Image size 2352x1568: 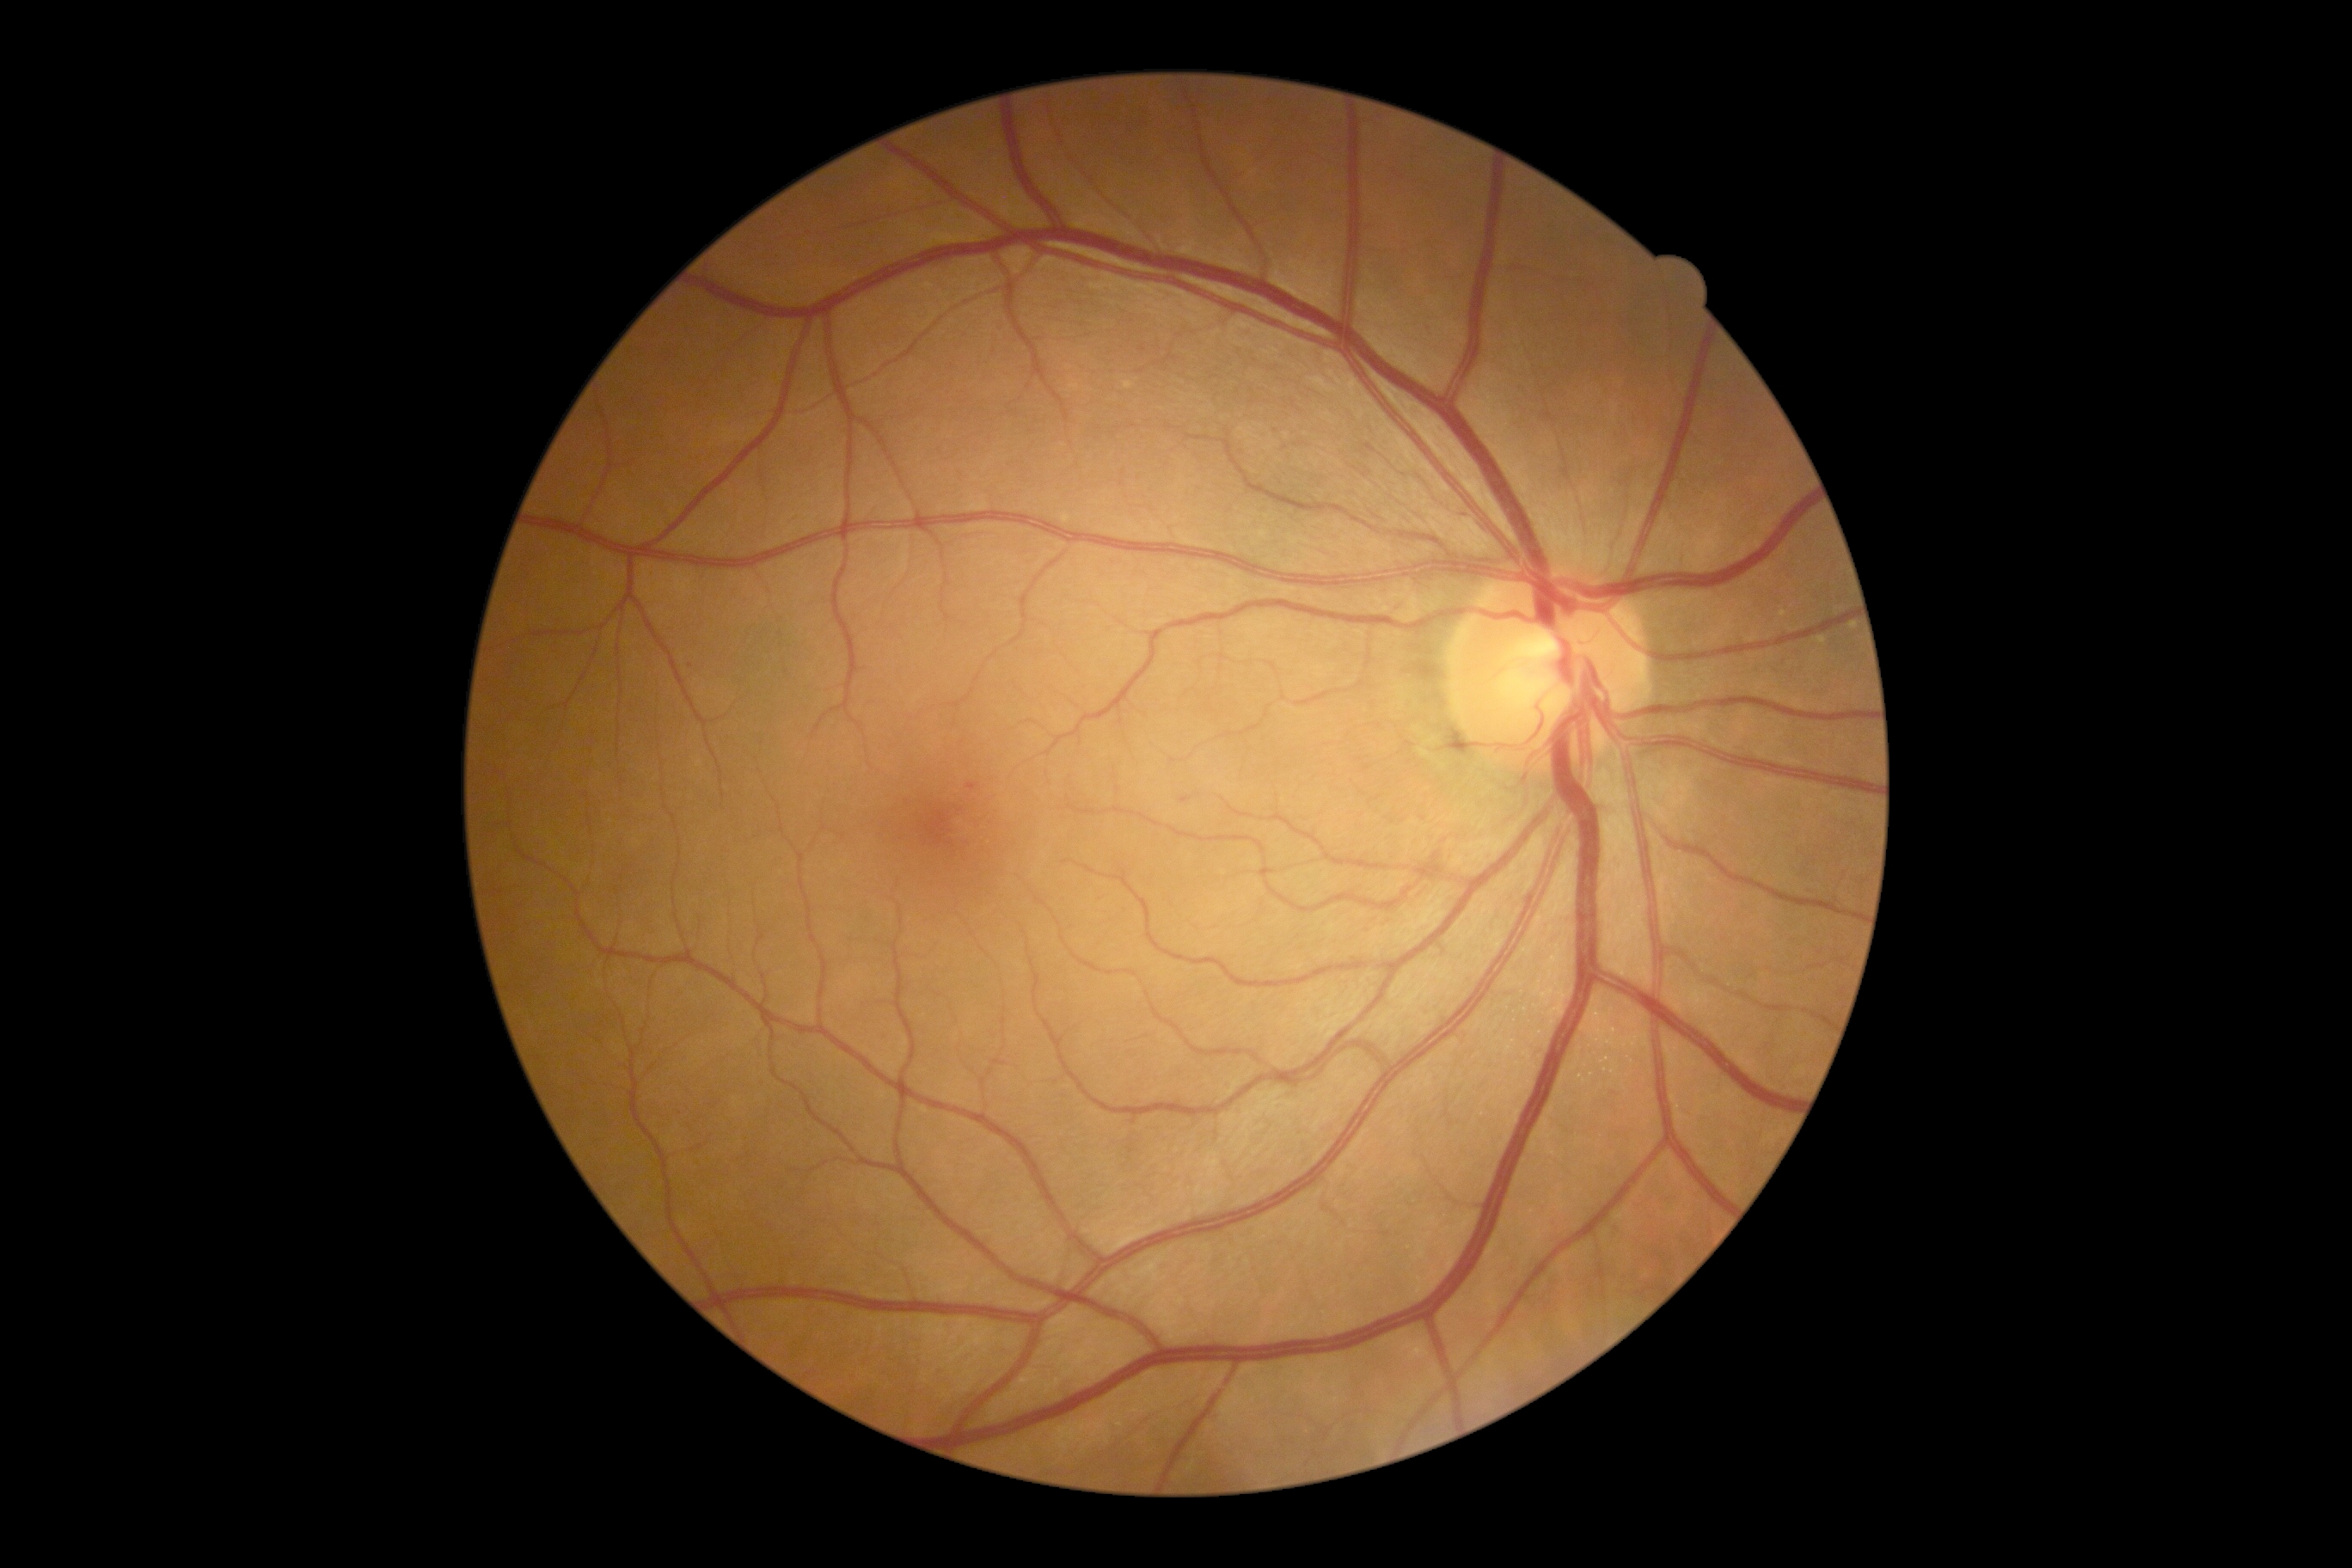 DR: 1/4 — presence of microaneurysms only.